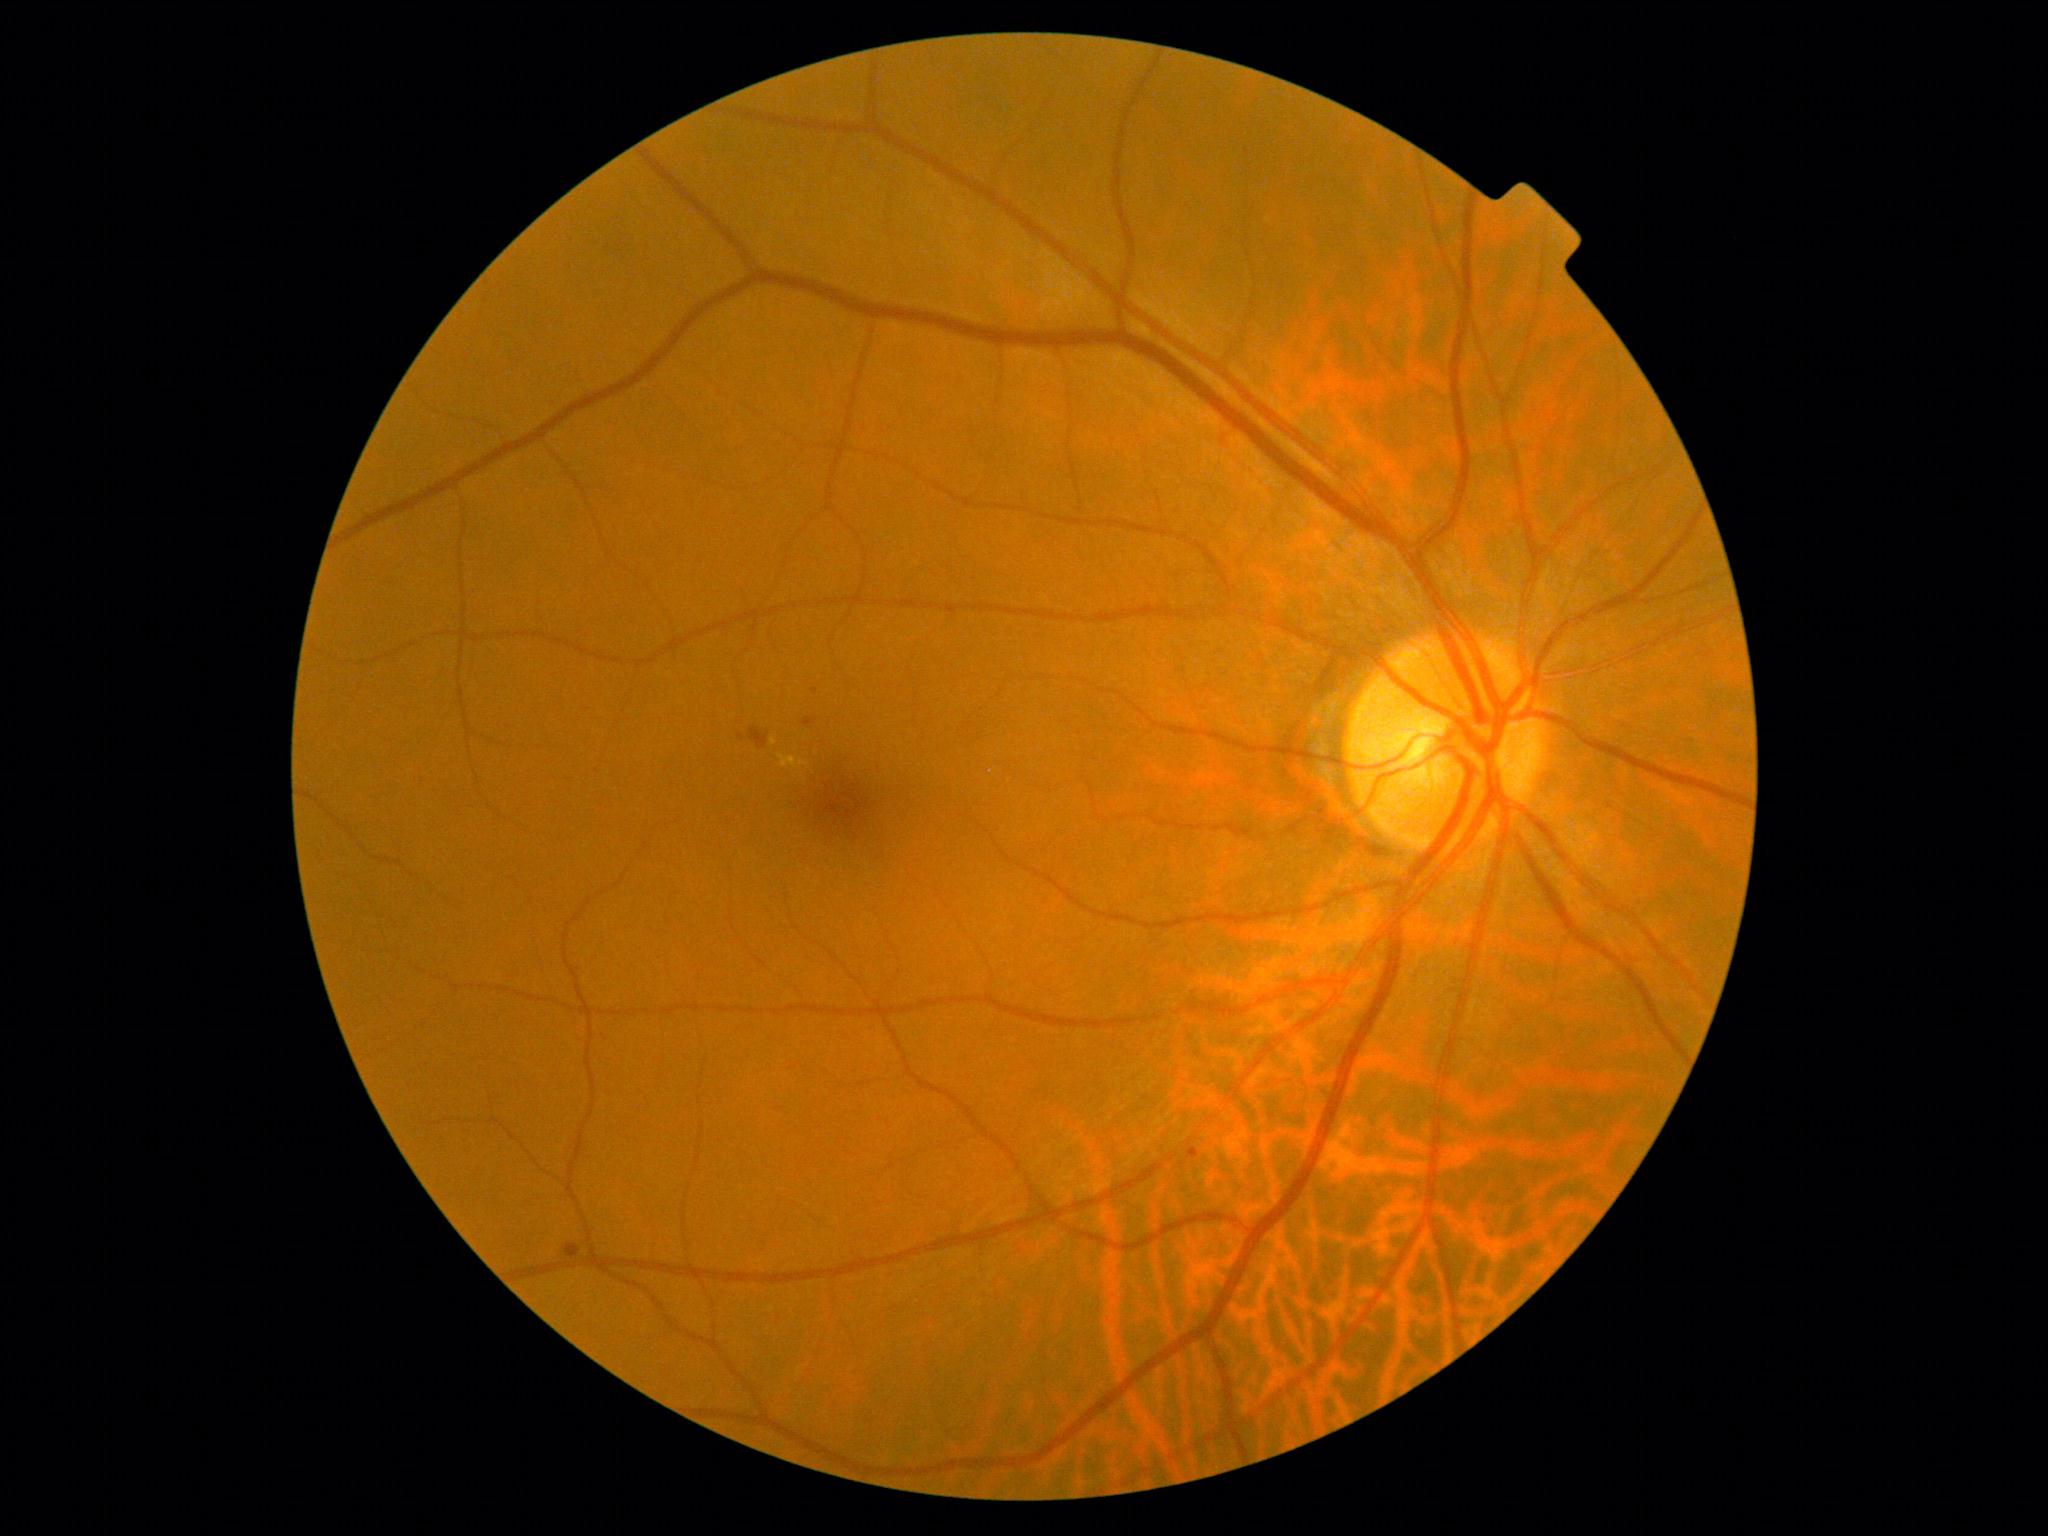 Diabetic retinopathy (DR) is grade 2 (moderate NPDR).